Camera: Phoenix ICON (100° FOV) · 1240x1240px · infant wide-field fundus photograph: 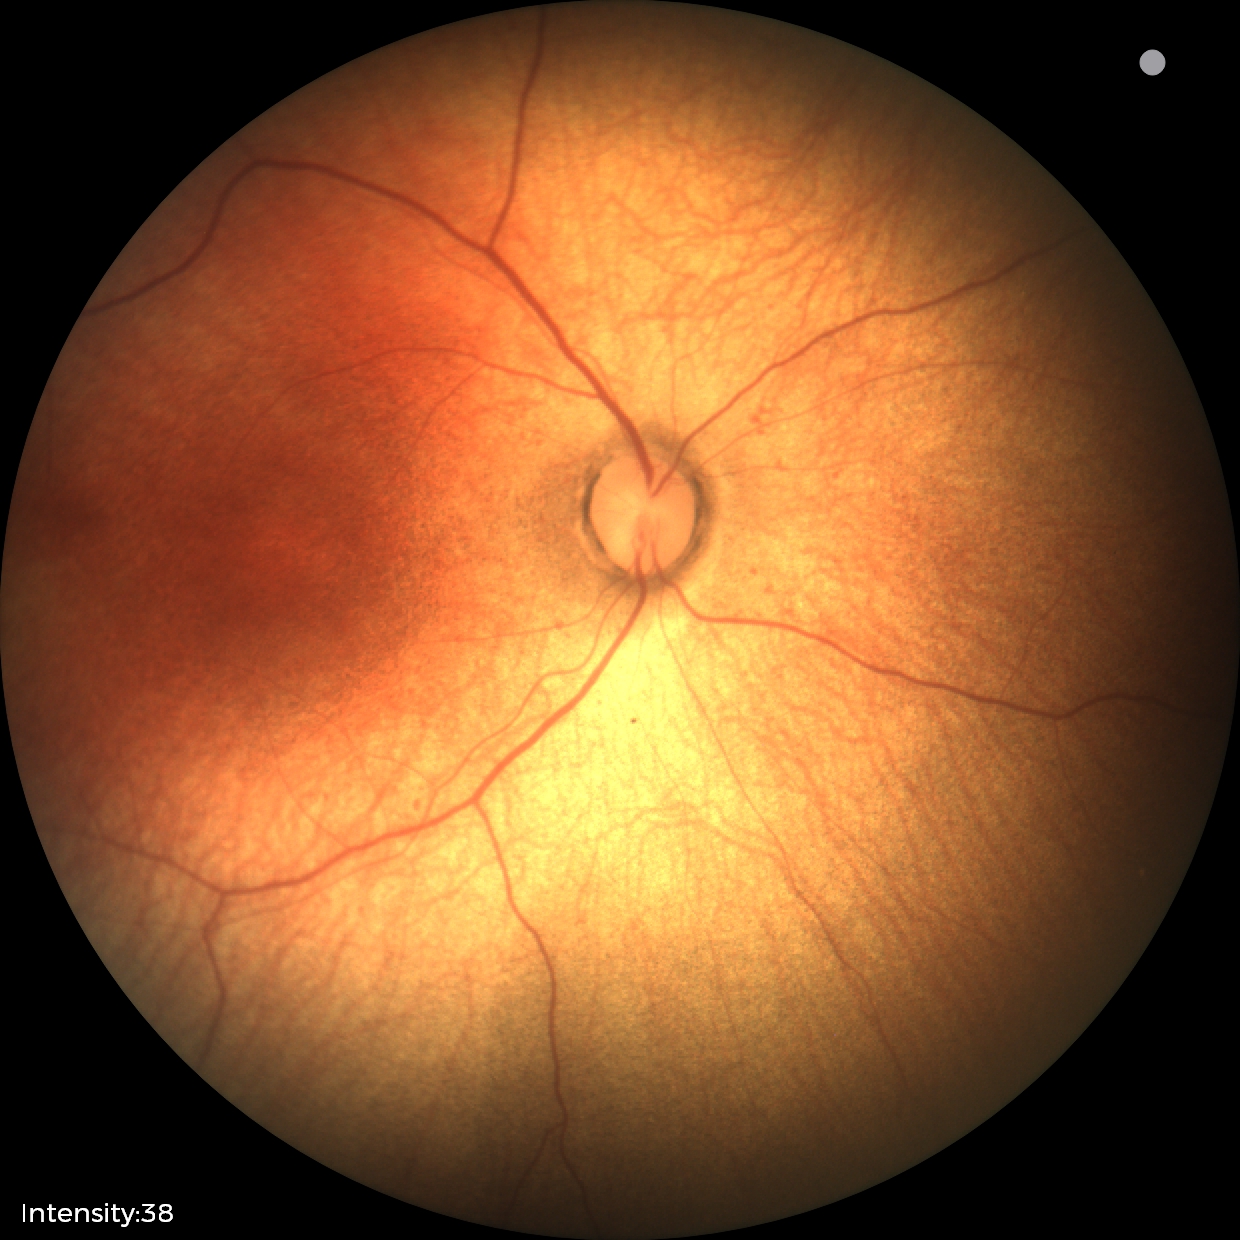 Q: What is the diagnosis from this examination?
A: physiological appearance with no retinal pathology